Fundus photo:
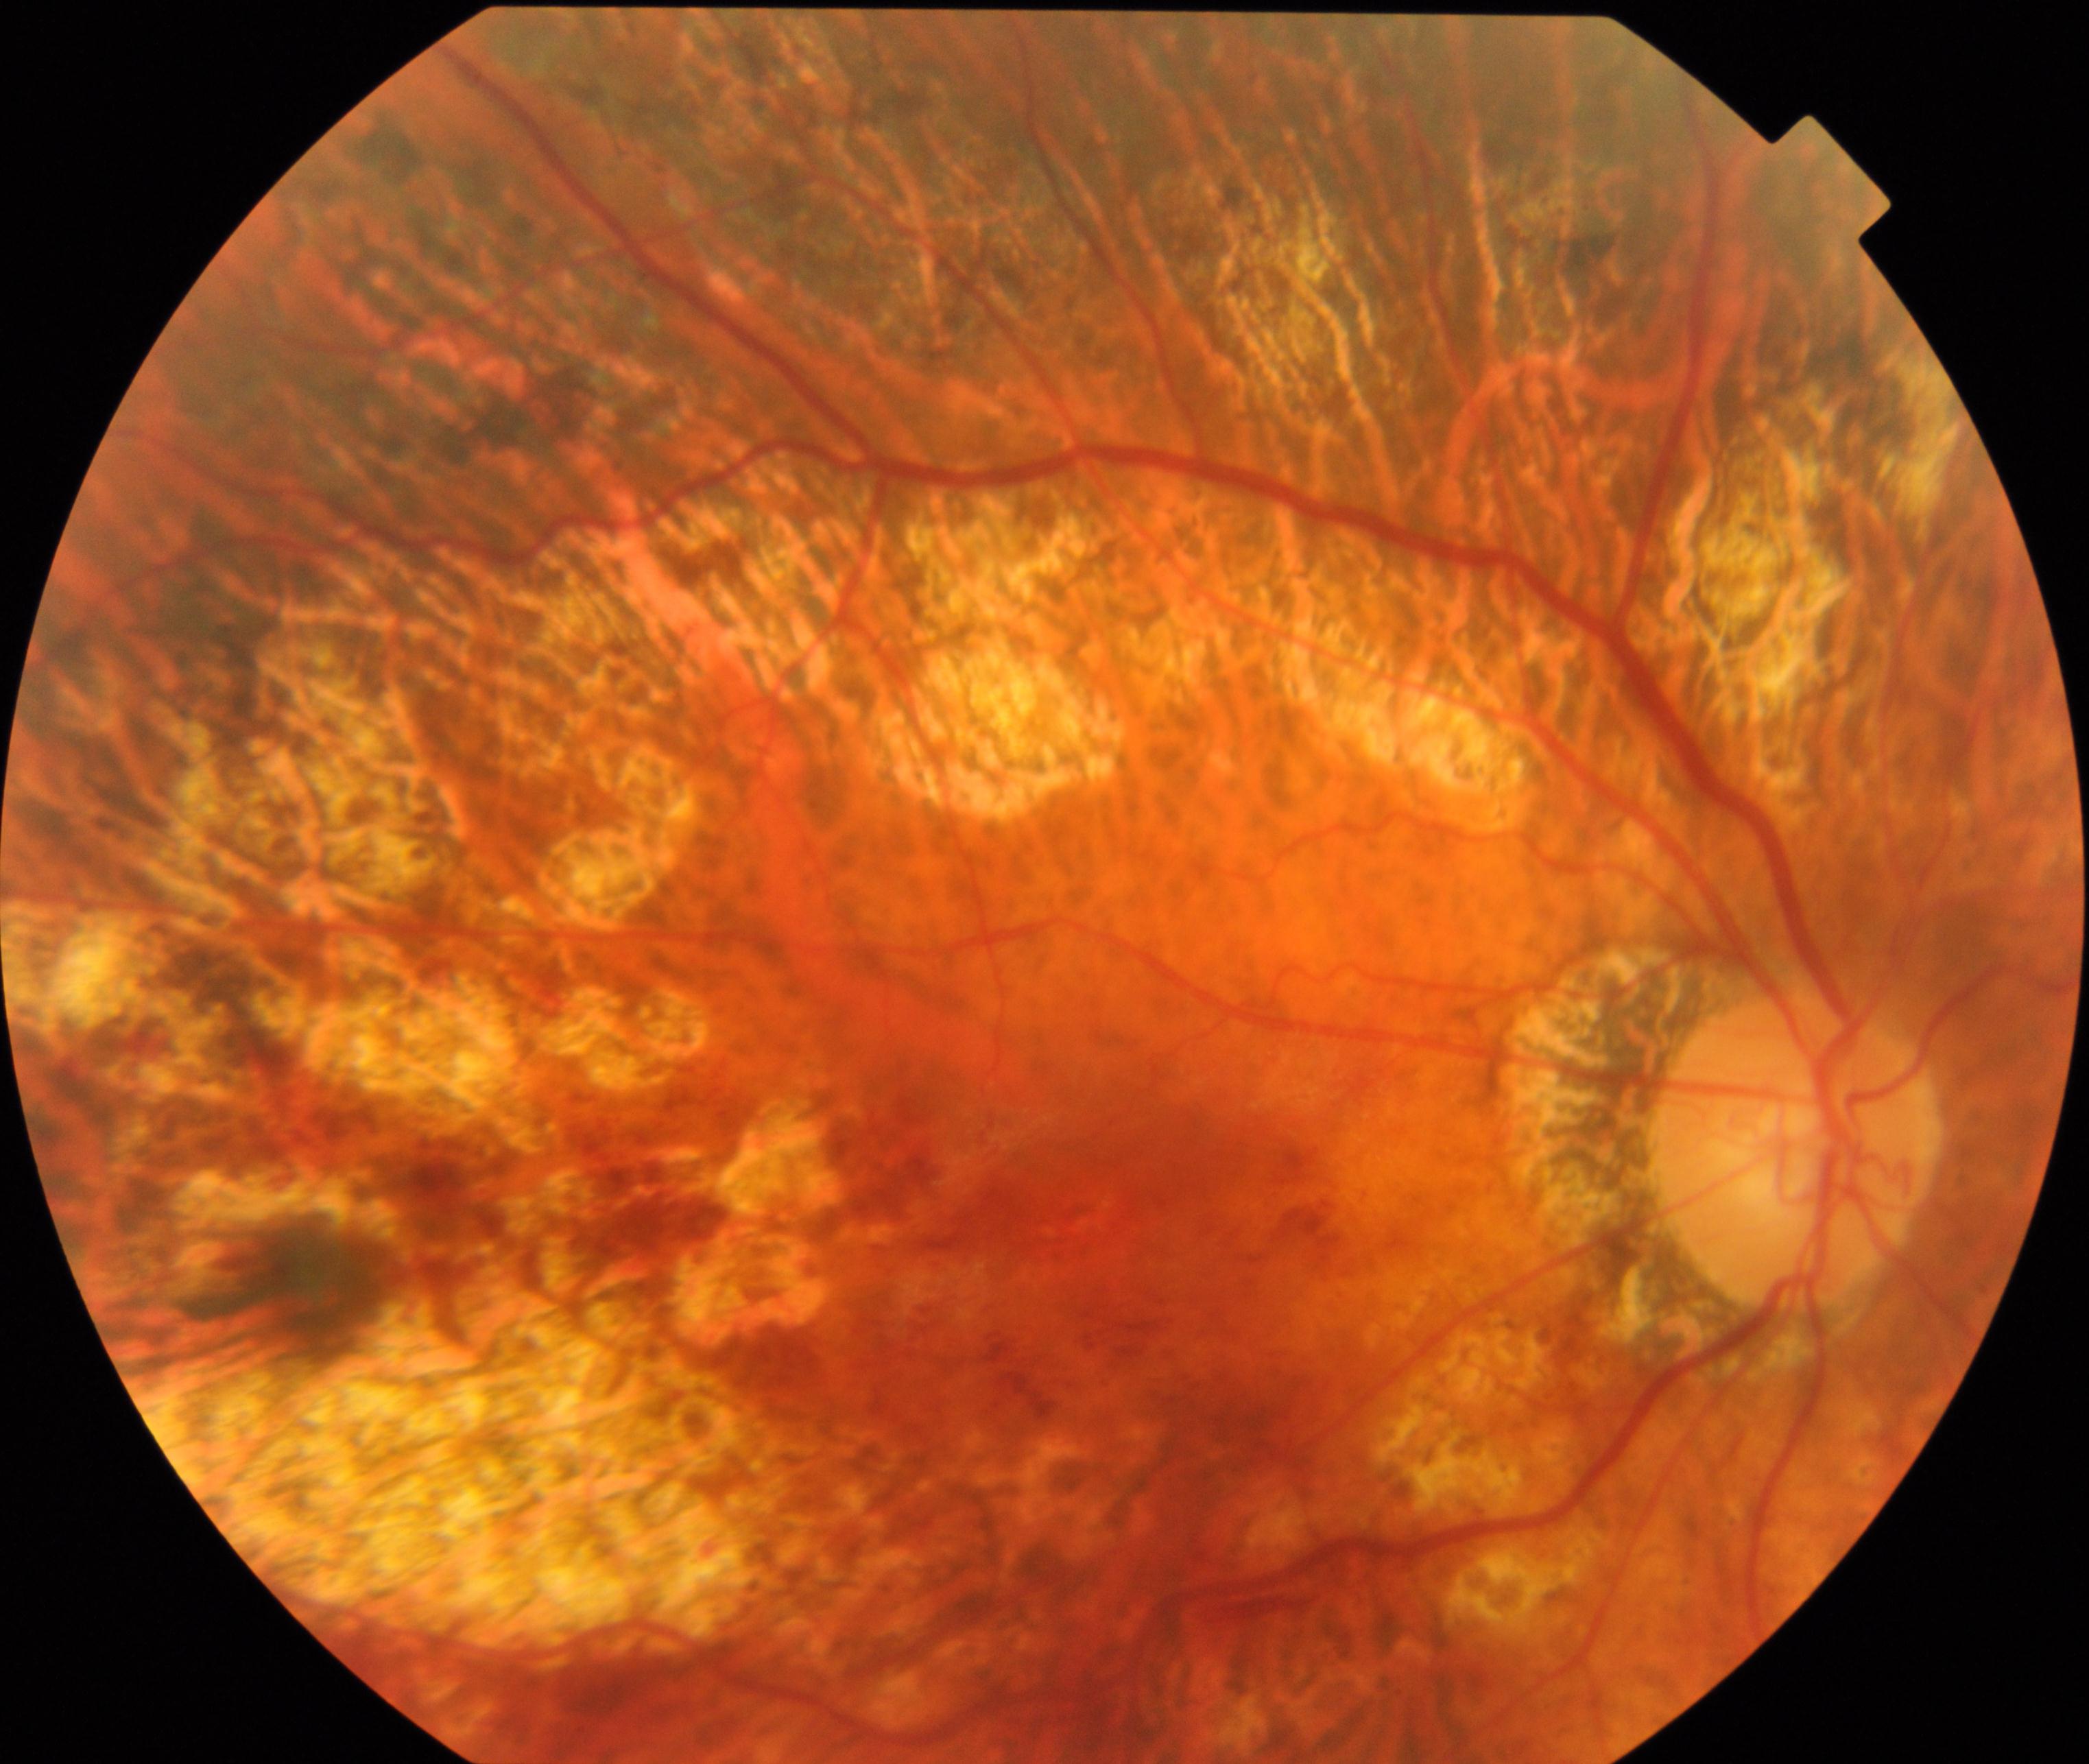
Classification: pathological myopia.